848x848. NIDEK AFC-230 fundus camera. 45° field of view:
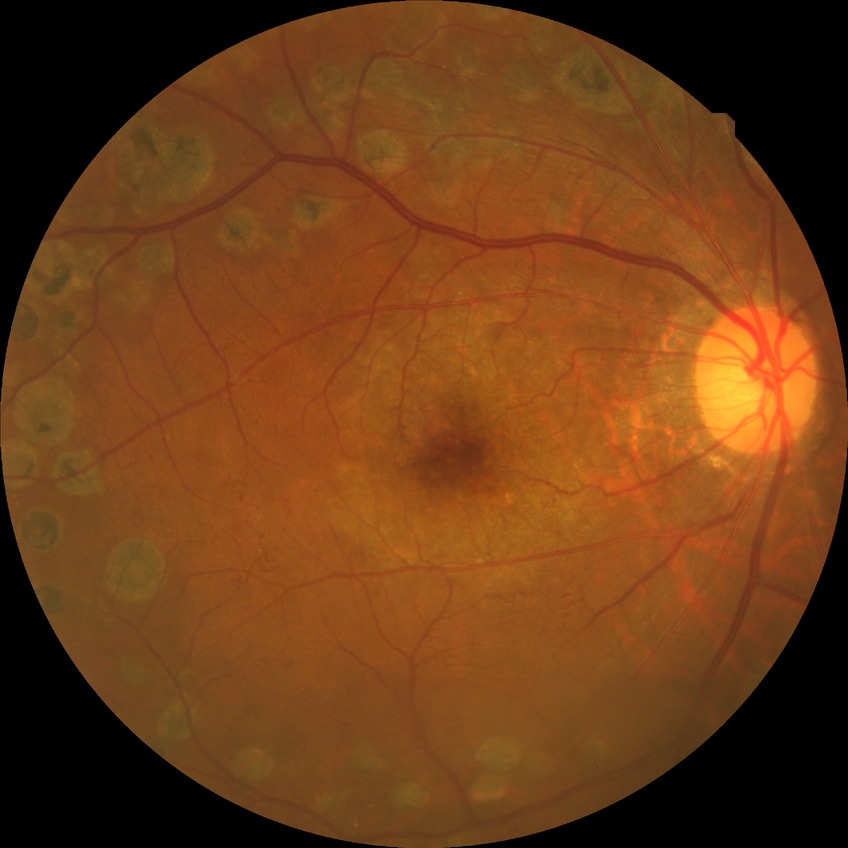
Findings:
• retinopathy grade: proliferative diabetic retinopathy